2212x1659px, color fundus photograph — 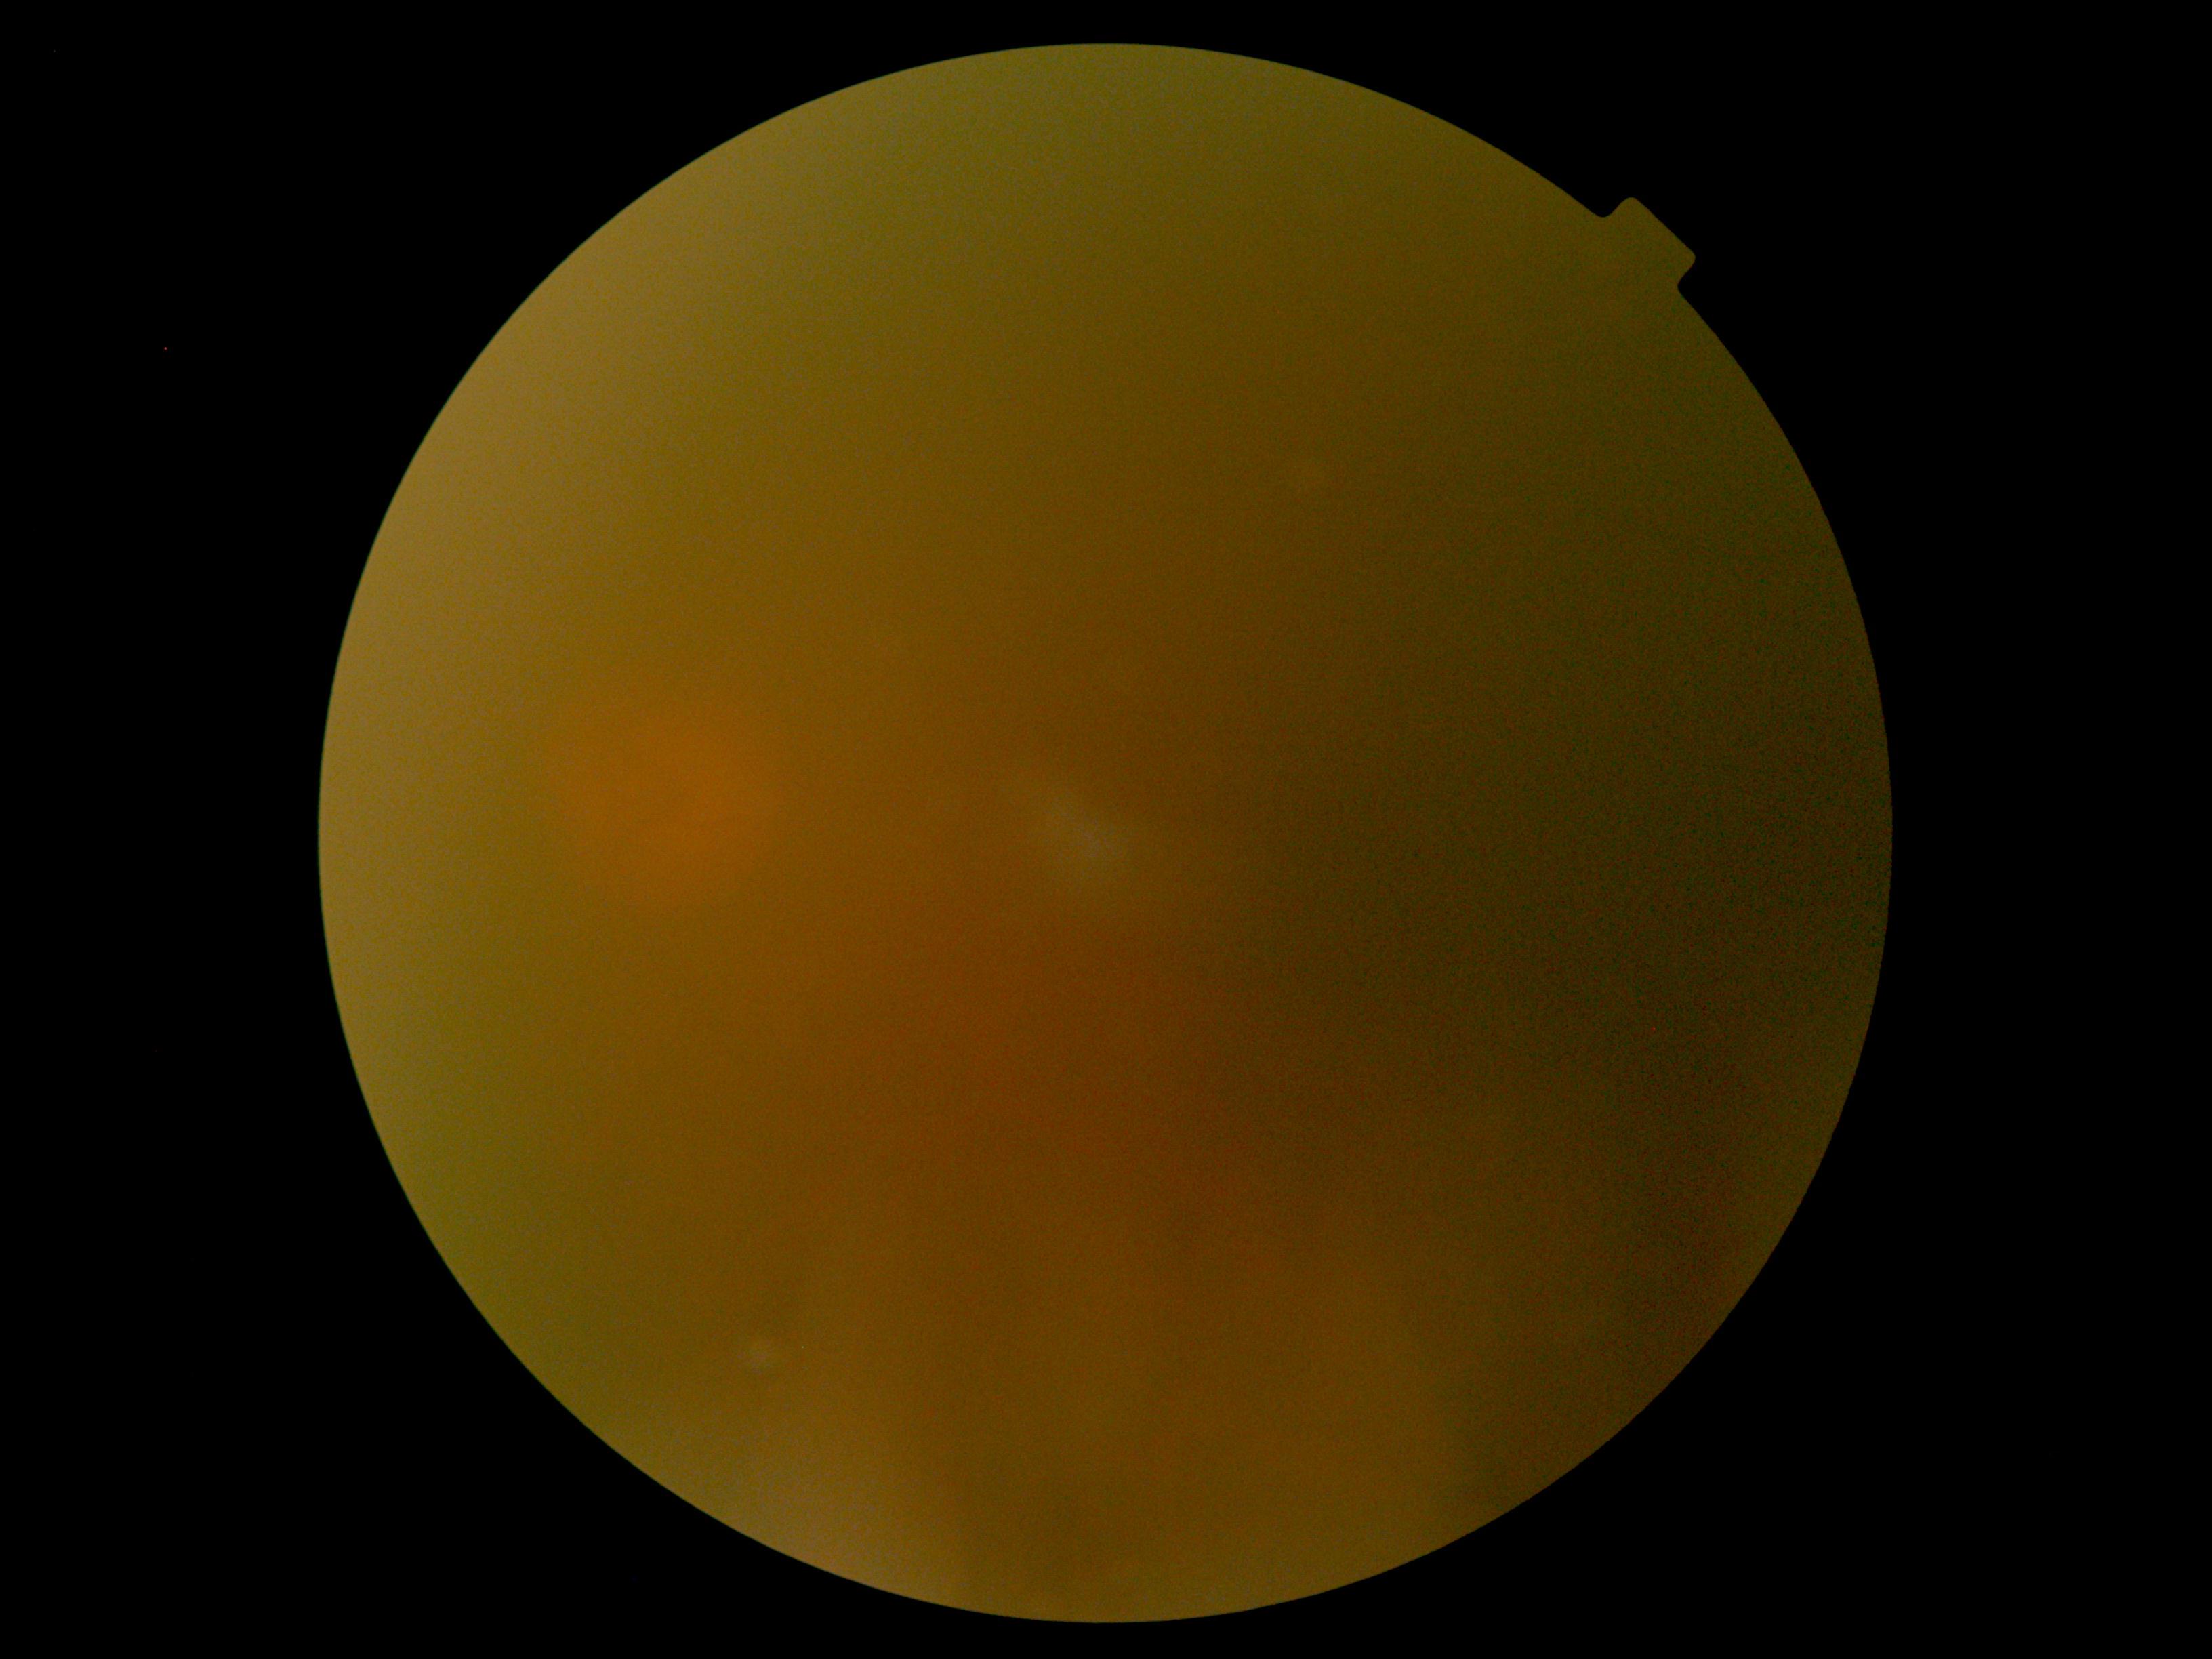

DR is ungradable.